Nonmydriatic fundus photograph
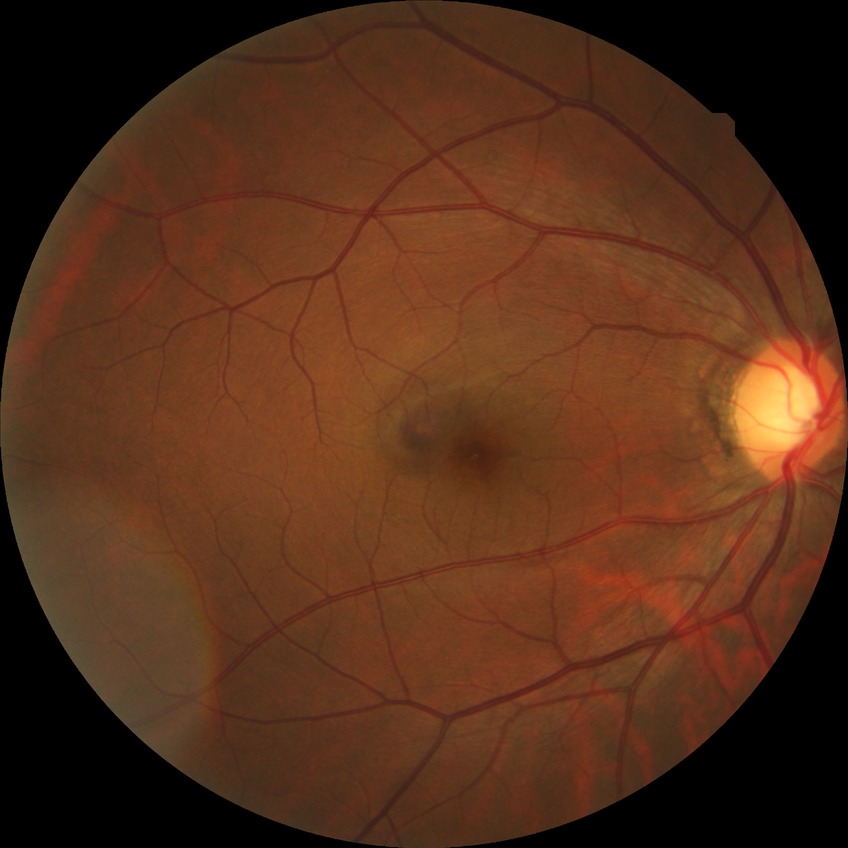
Retinopathy stage: no diabetic retinopathy.